Acquired with a Remidio FOP fundus camera:
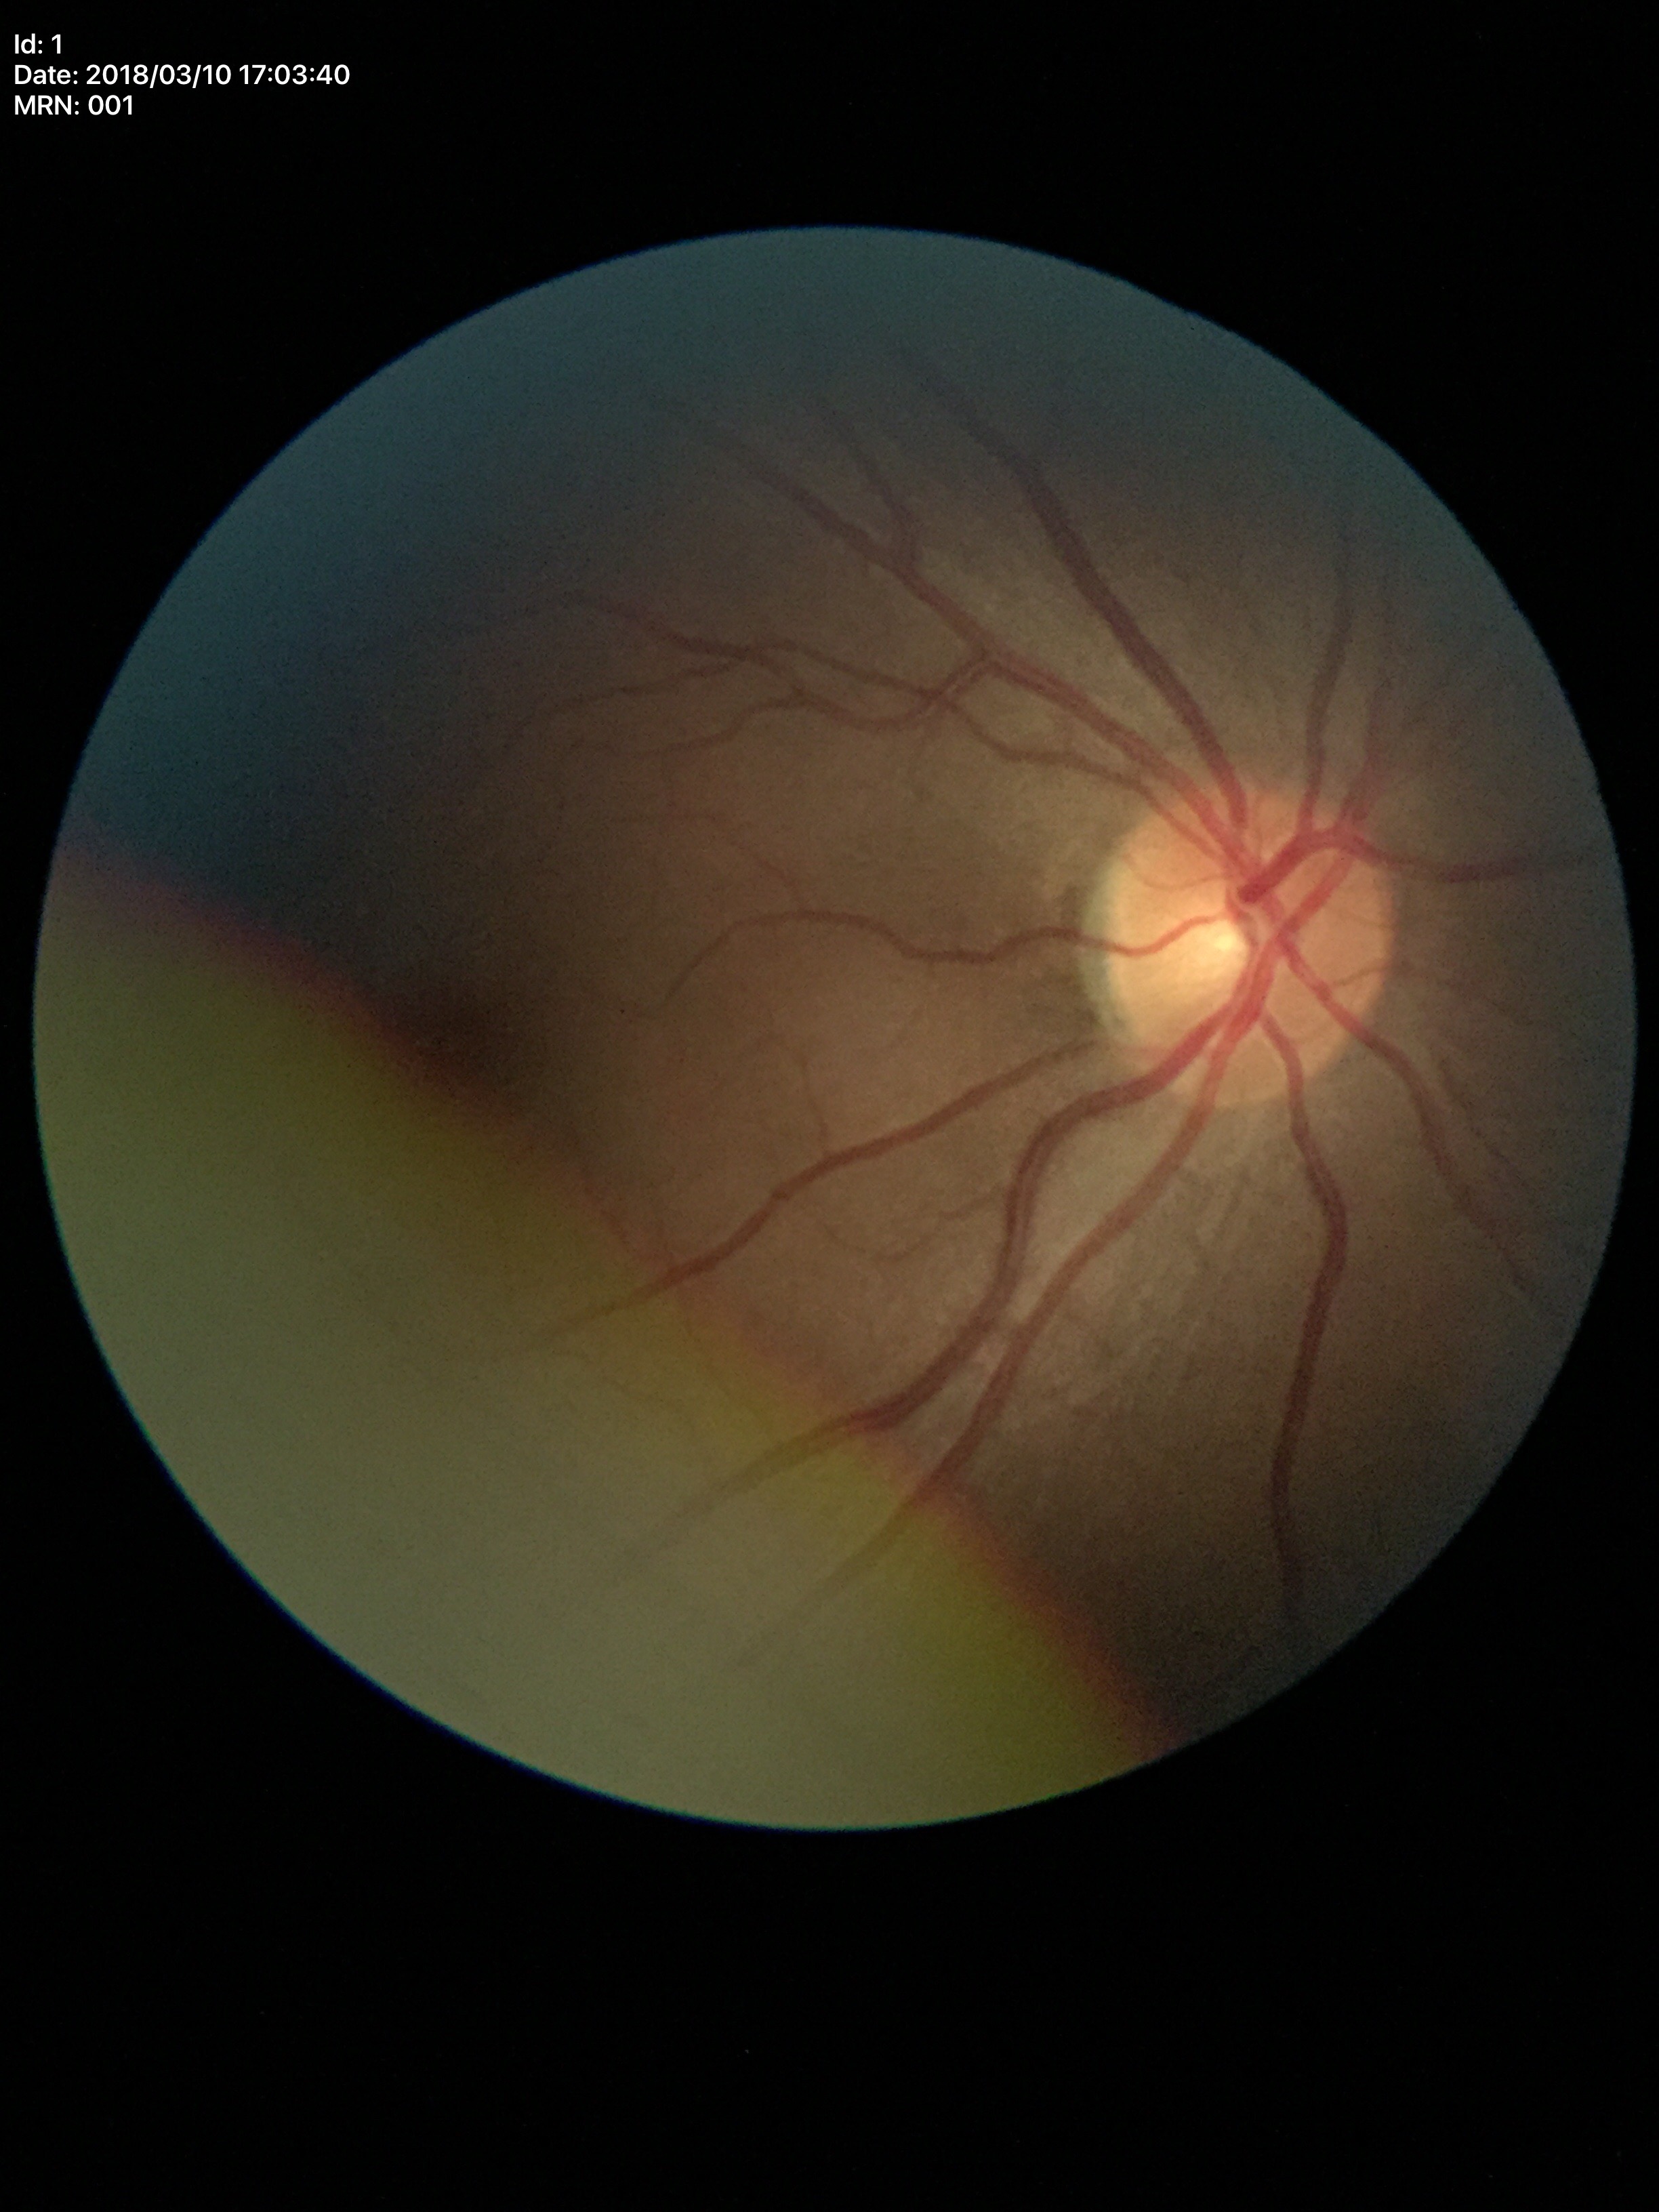 Glaucoma assessment: negative (5/5 ophthalmologists in agreement). Vertical cup-to-disc ratio is 0.47. Horizontal C/D ratio is 0.47.